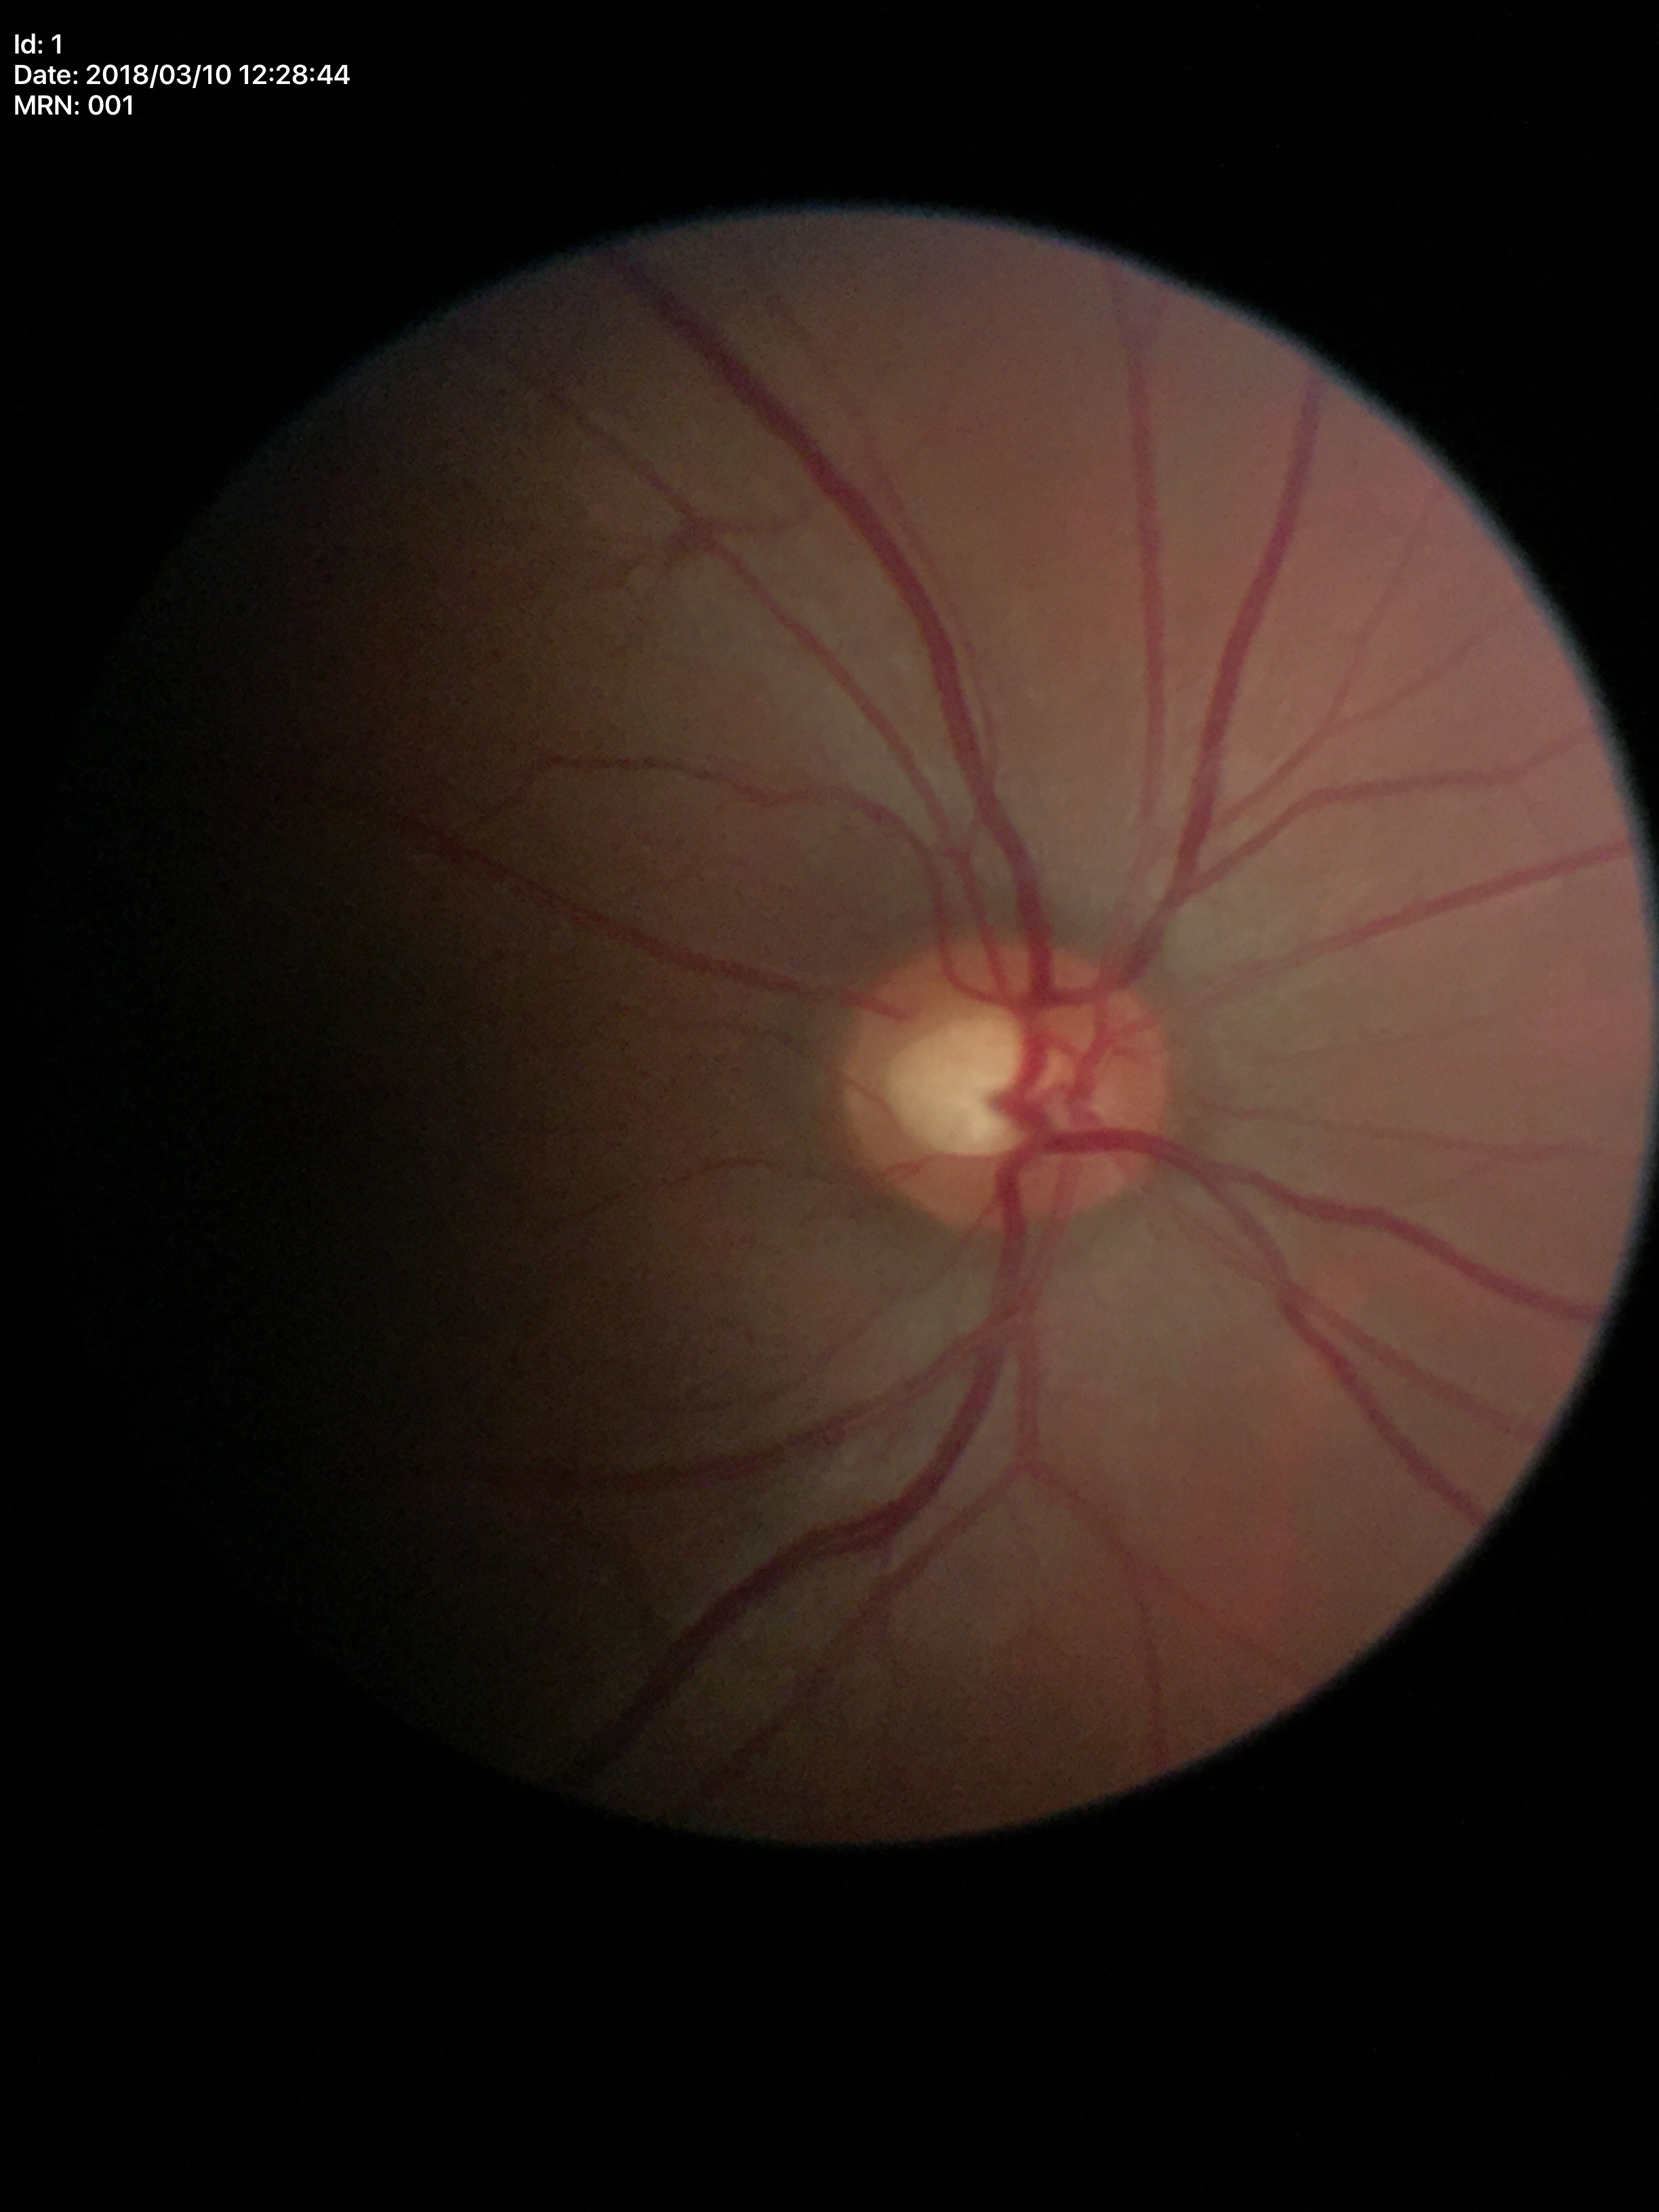

Glaucoma screening impression = not suspect (all 5 graders called normal) | vertical cup-disc ratio = 0.54.